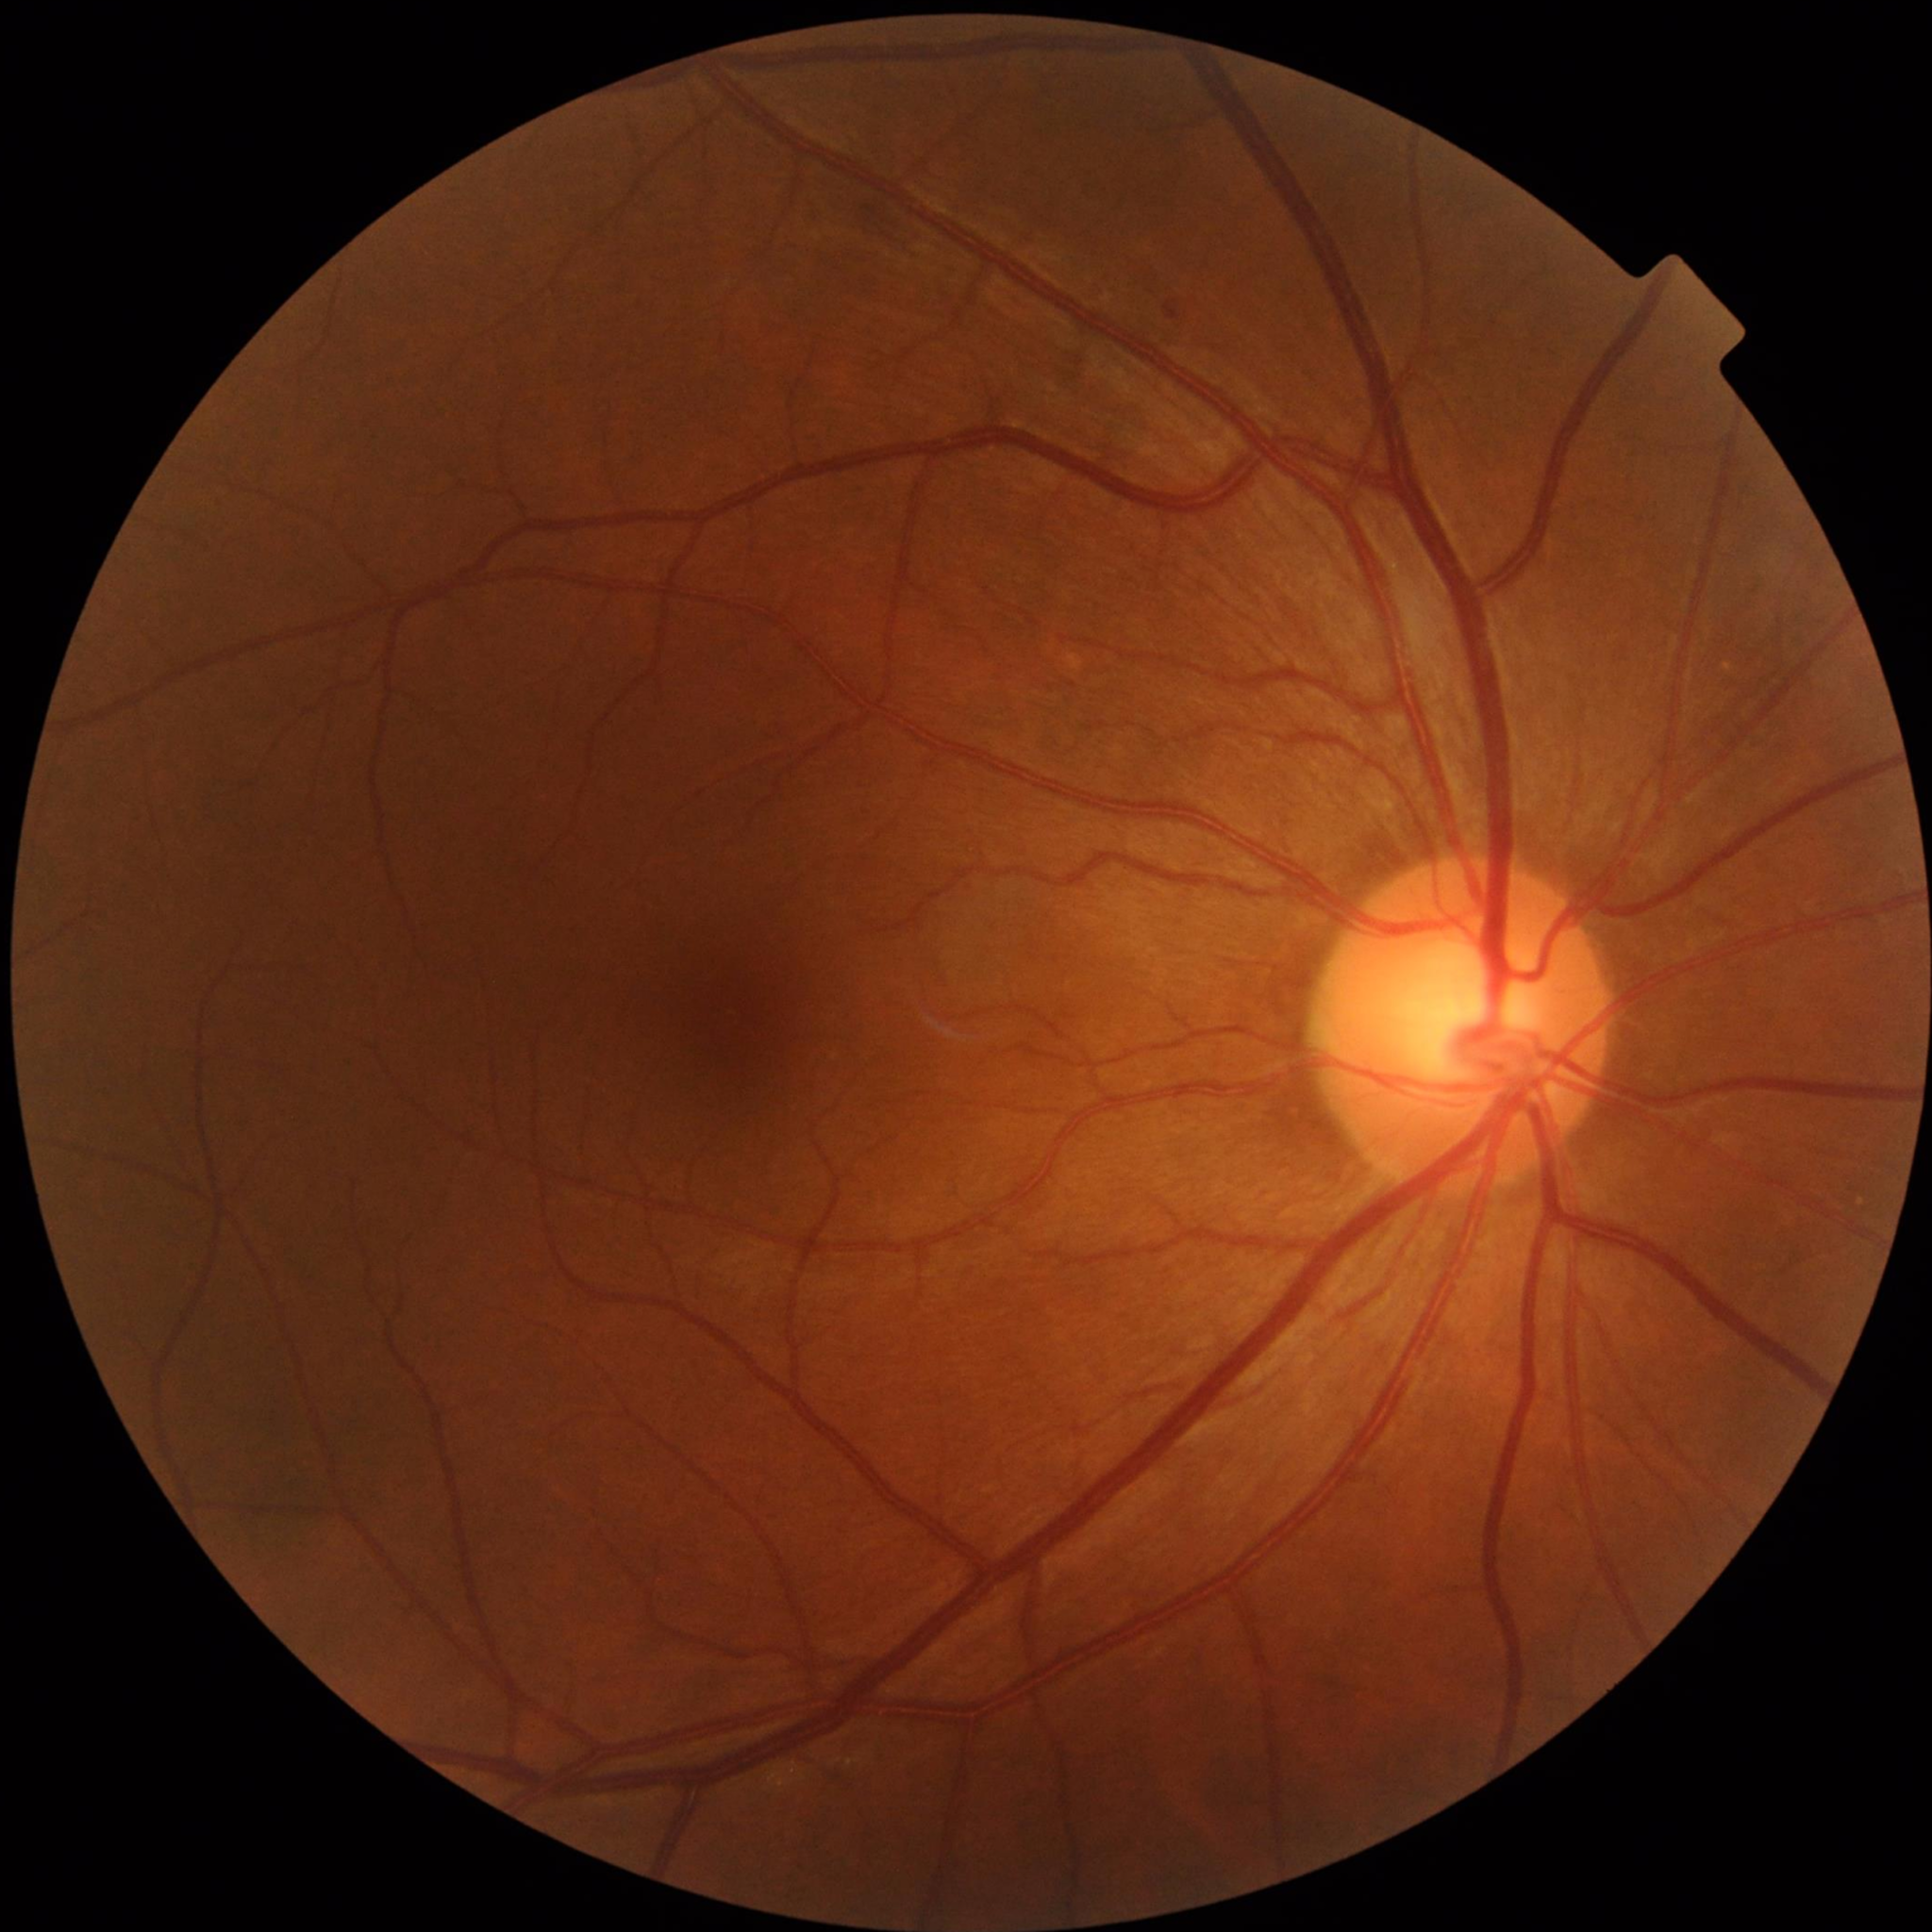 Disease class: no AMD, DR, or glaucoma